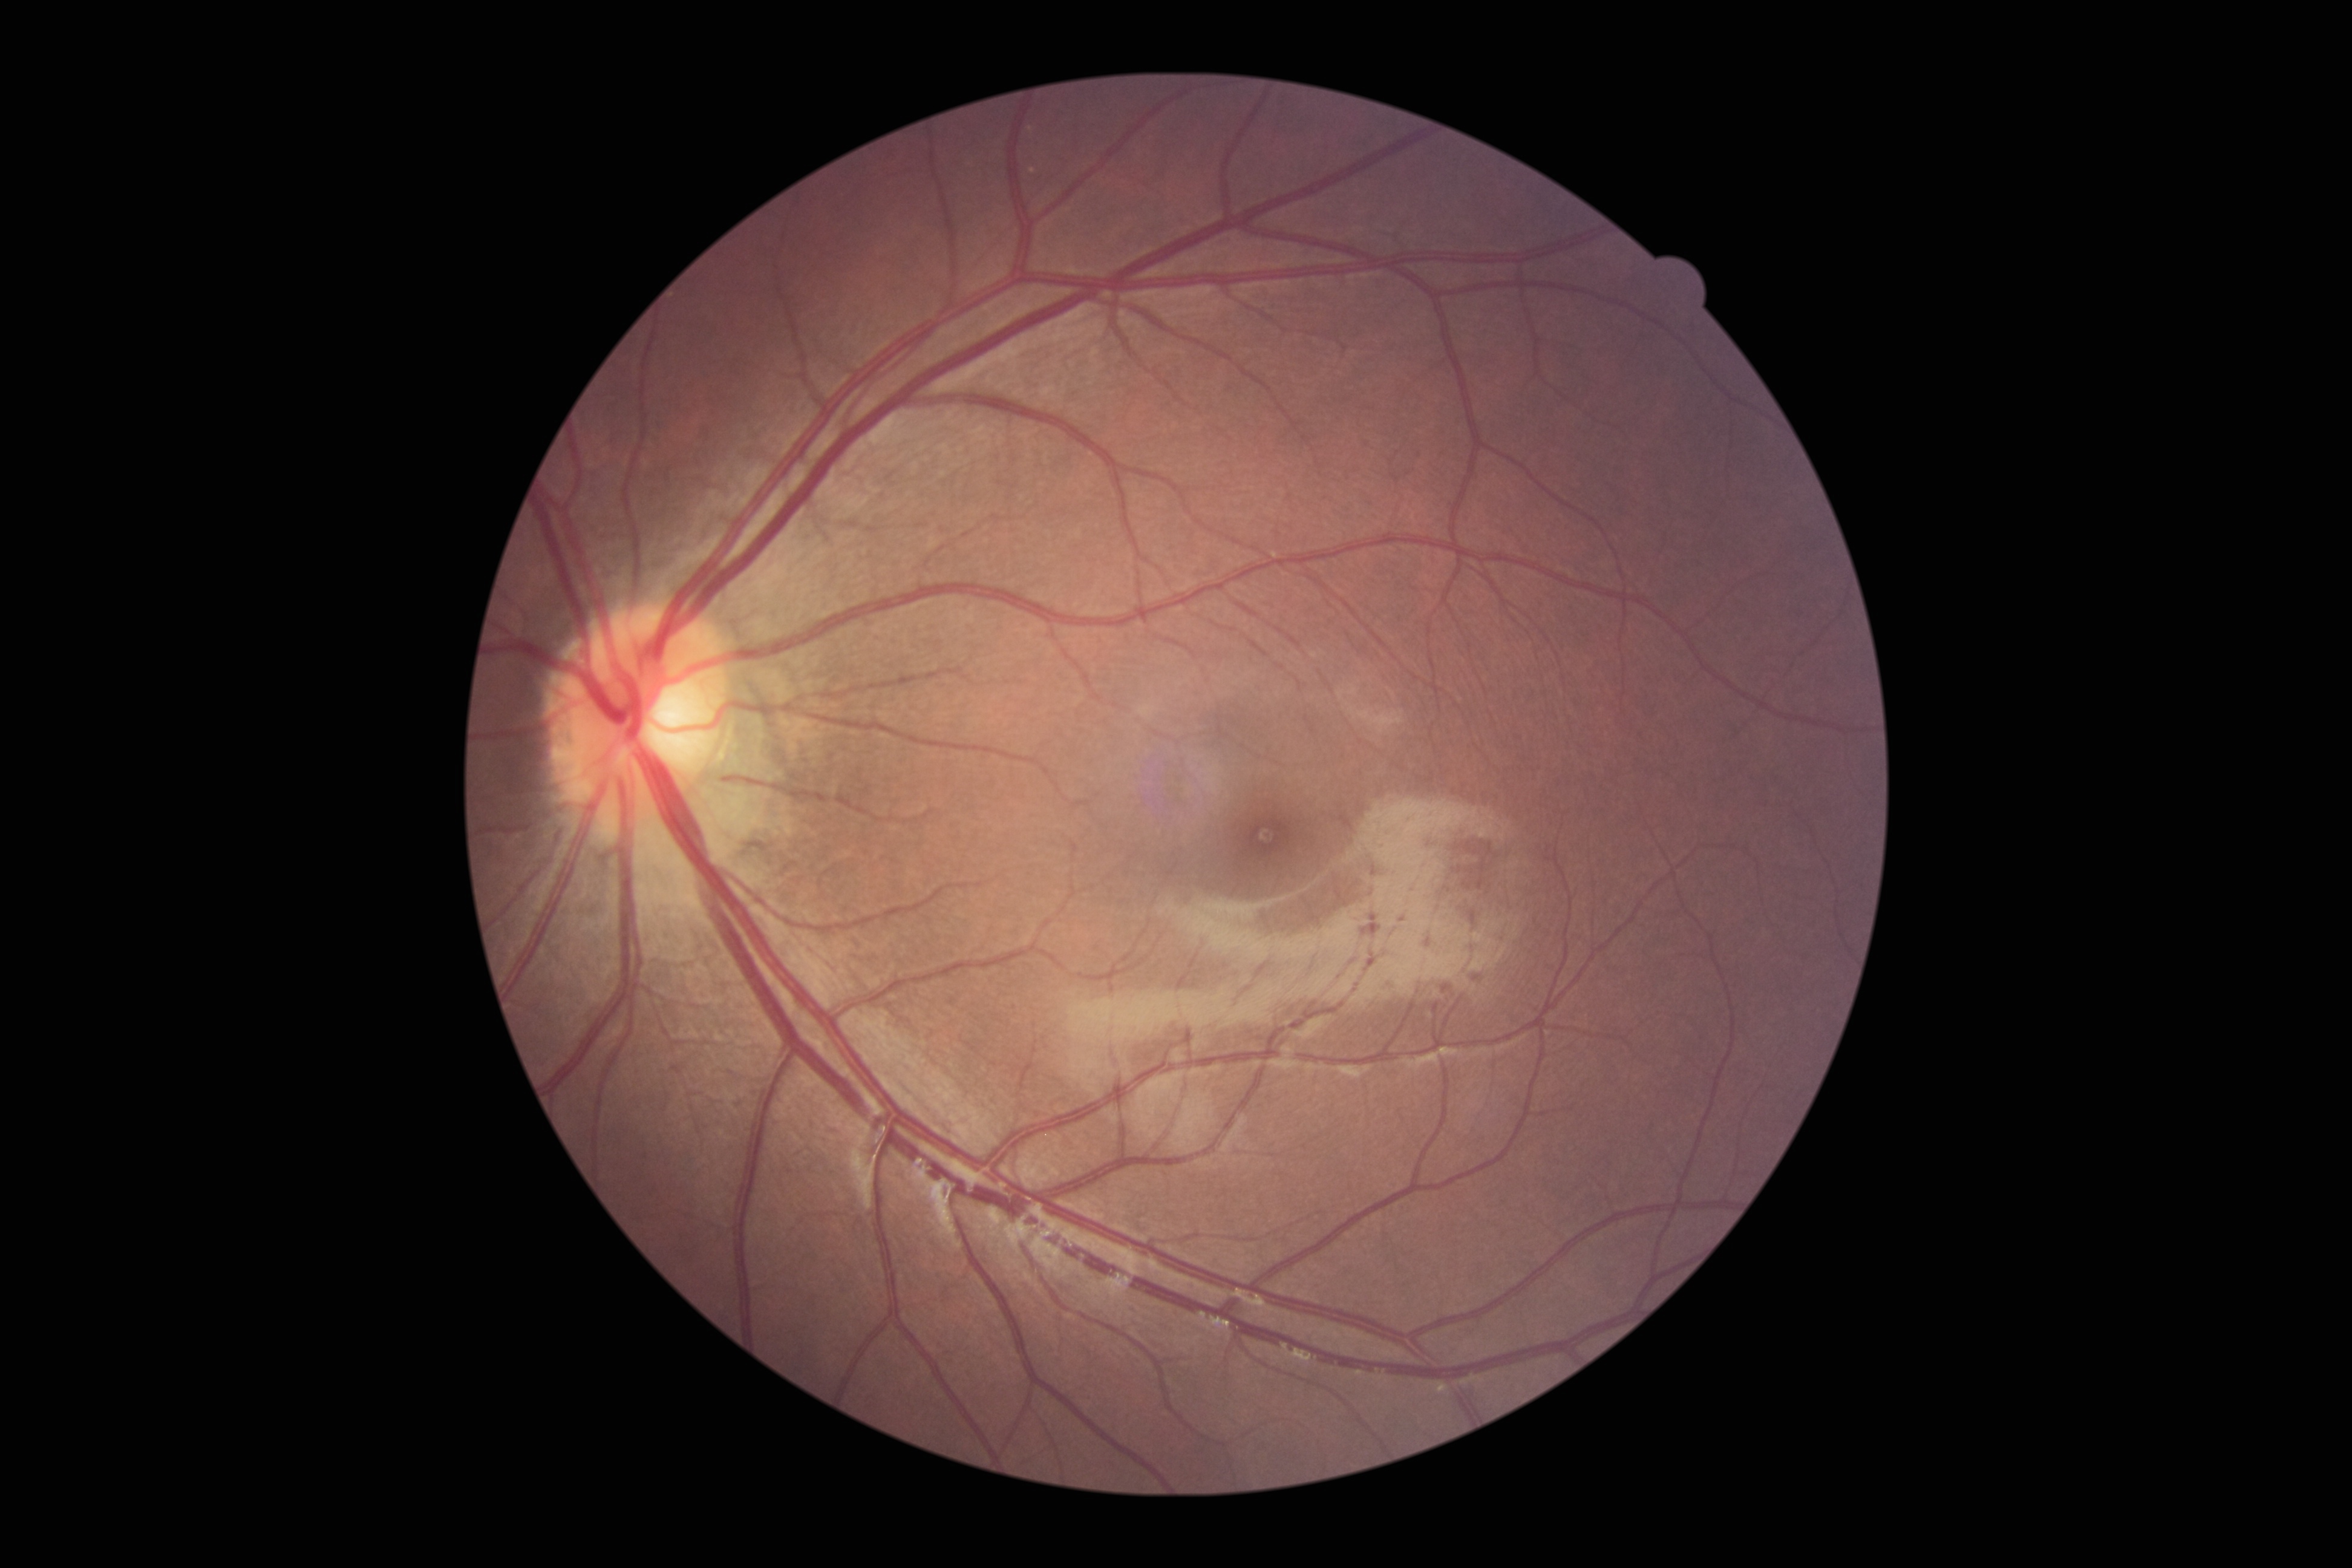
DR@grade 0 (no apparent retinopathy) — no visible signs of diabetic retinopathy; DR impression@no apparent DR.